NIDEK AFC-230 fundus camera; 848 by 848 pixels:
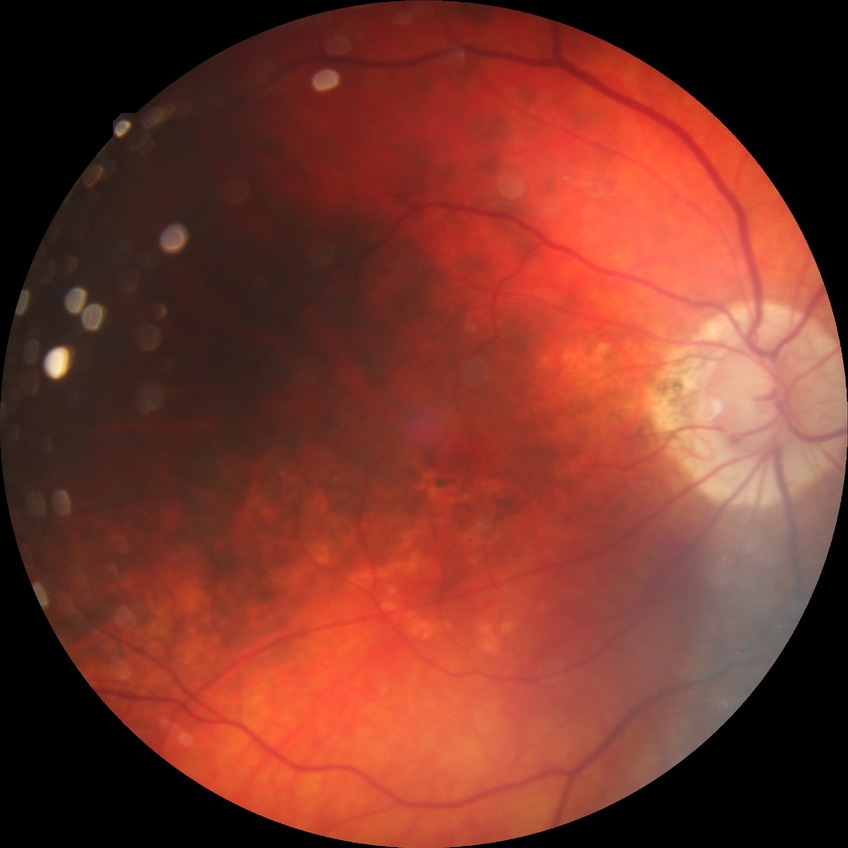
{"davis_grade": "no diabetic retinopathy"}